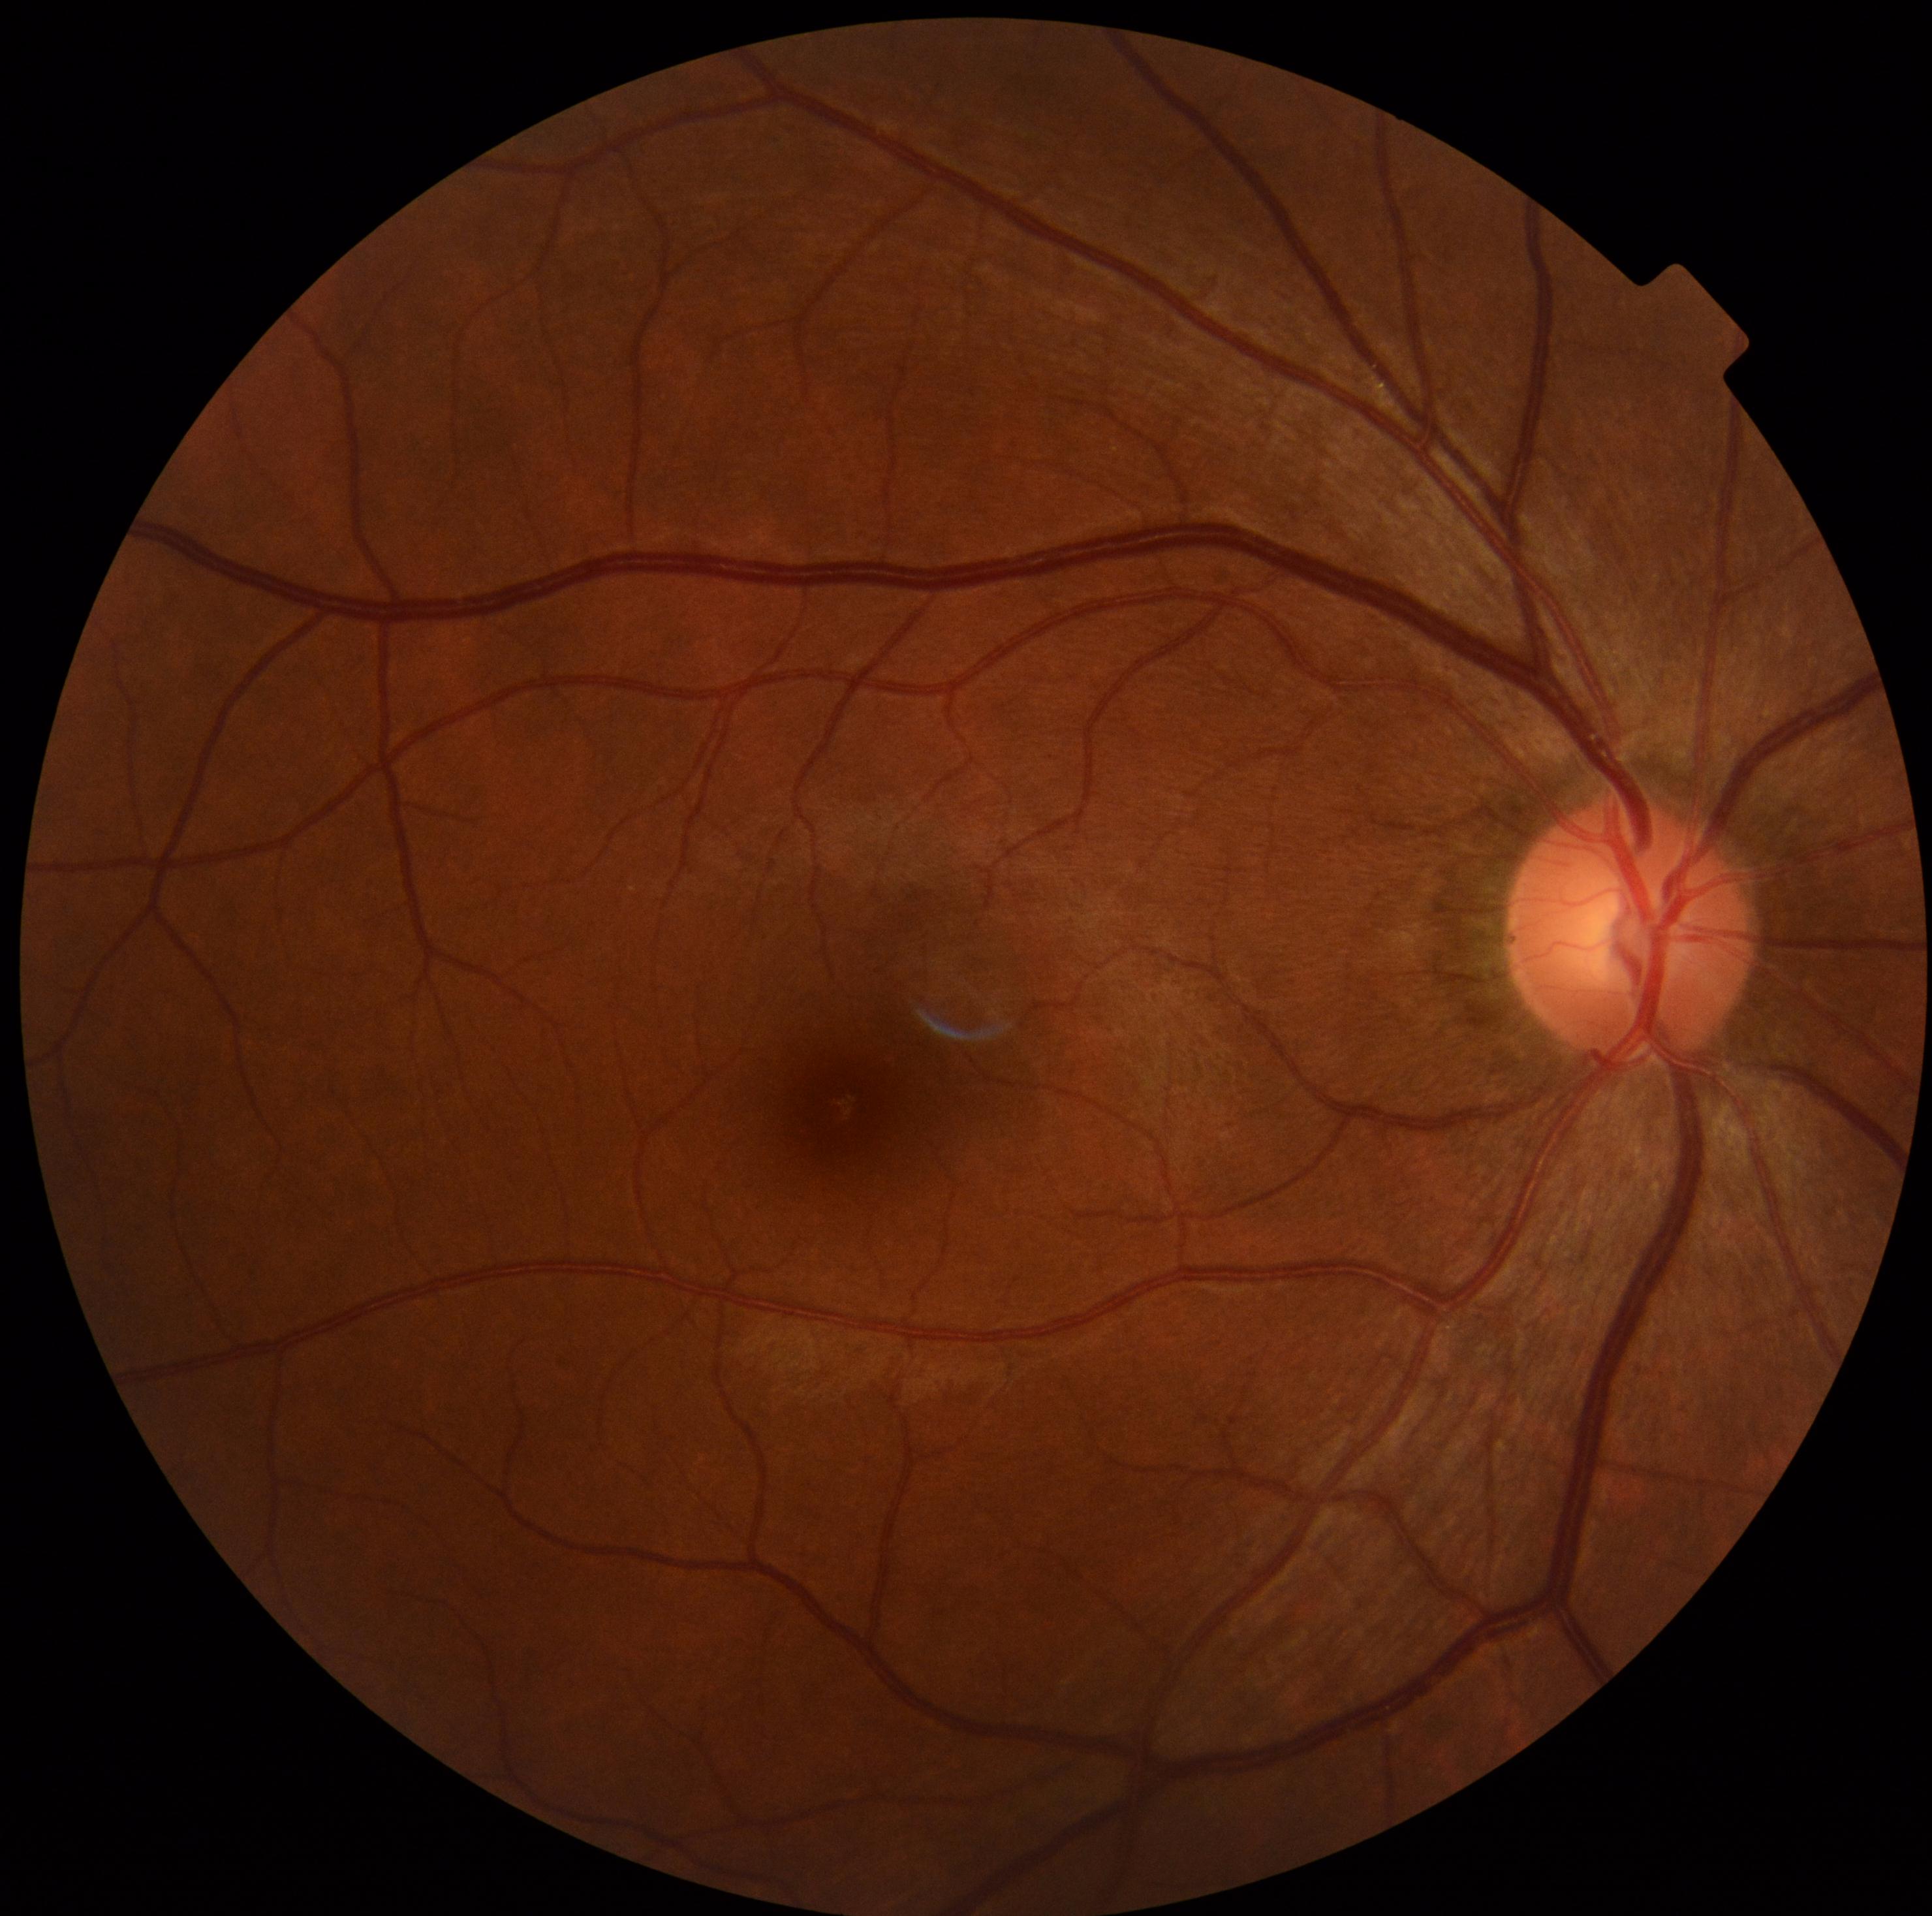
DR impression: no signs of DR; diabetic retinopathy: grade 0 (no apparent retinopathy).